Macula-centered field · captured on a Kowa VX-10α fundus camera · captured after pupil dilation · 2361x1568:
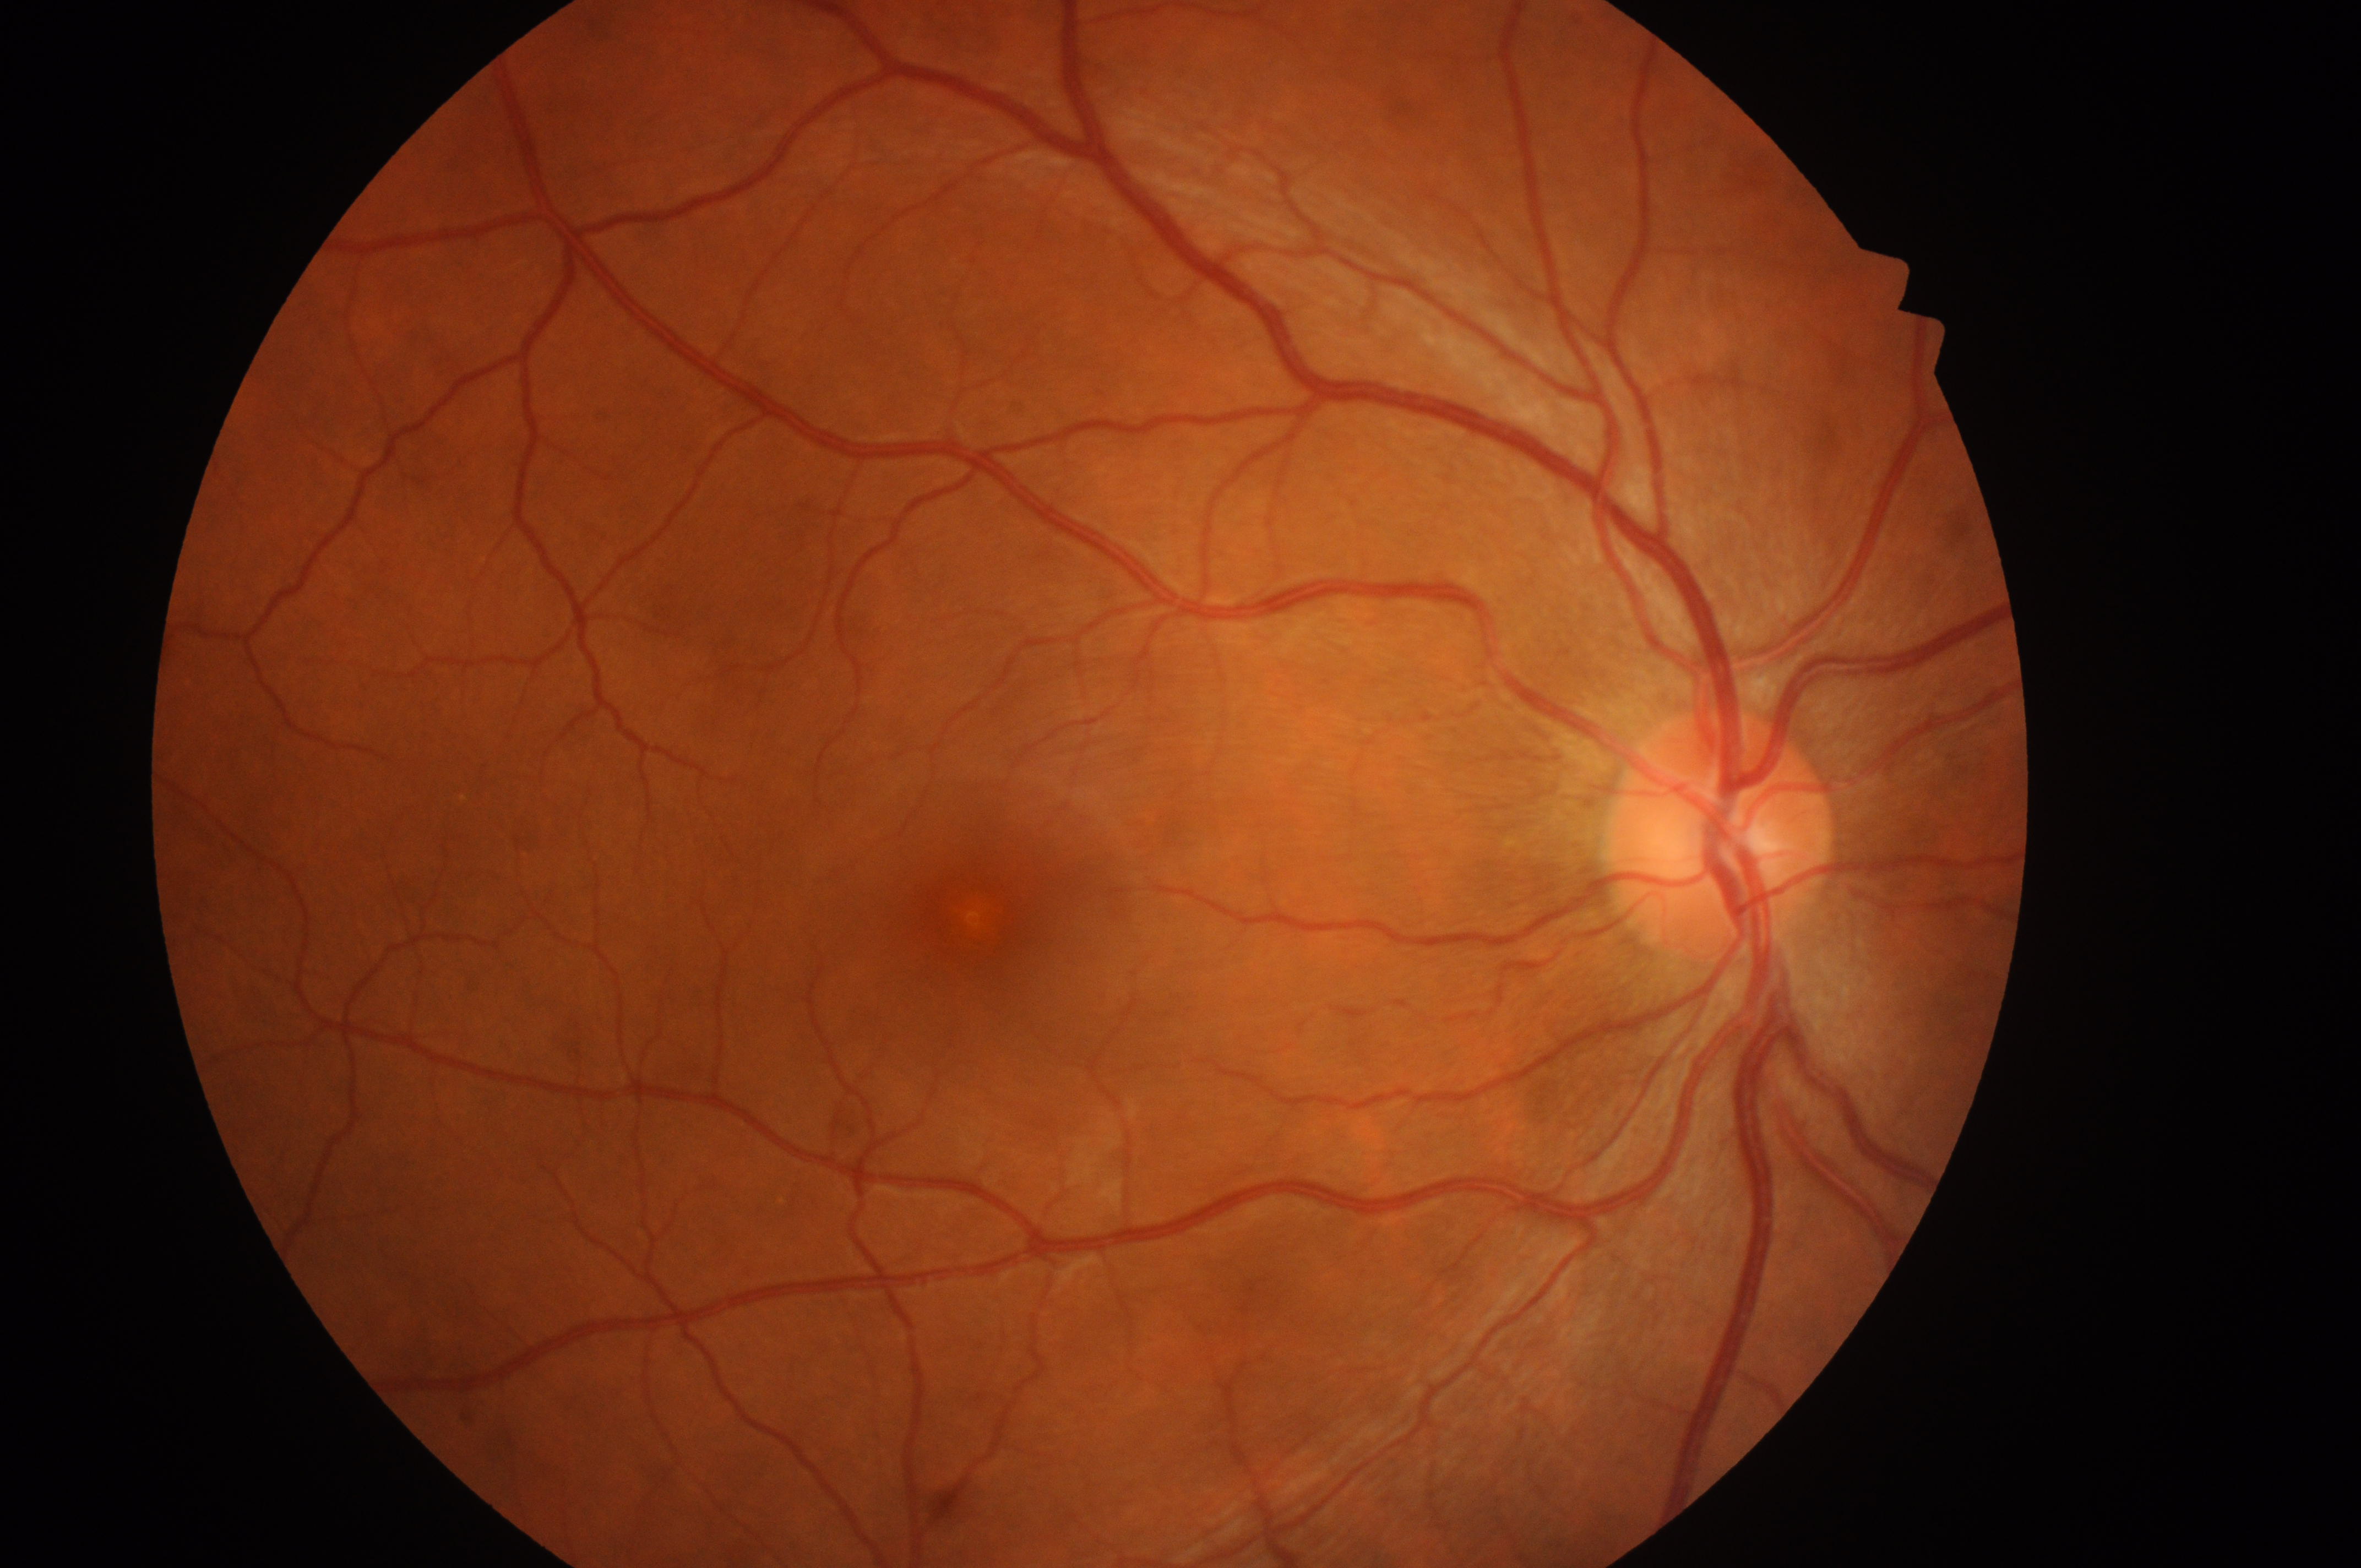
The image shows the right eye. DME risk: no risk (grade 0). DR: grade 0 (no apparent retinopathy). The foveal center is at 967, 913. Optic disc center located at 1720, 847.